45° field of view — 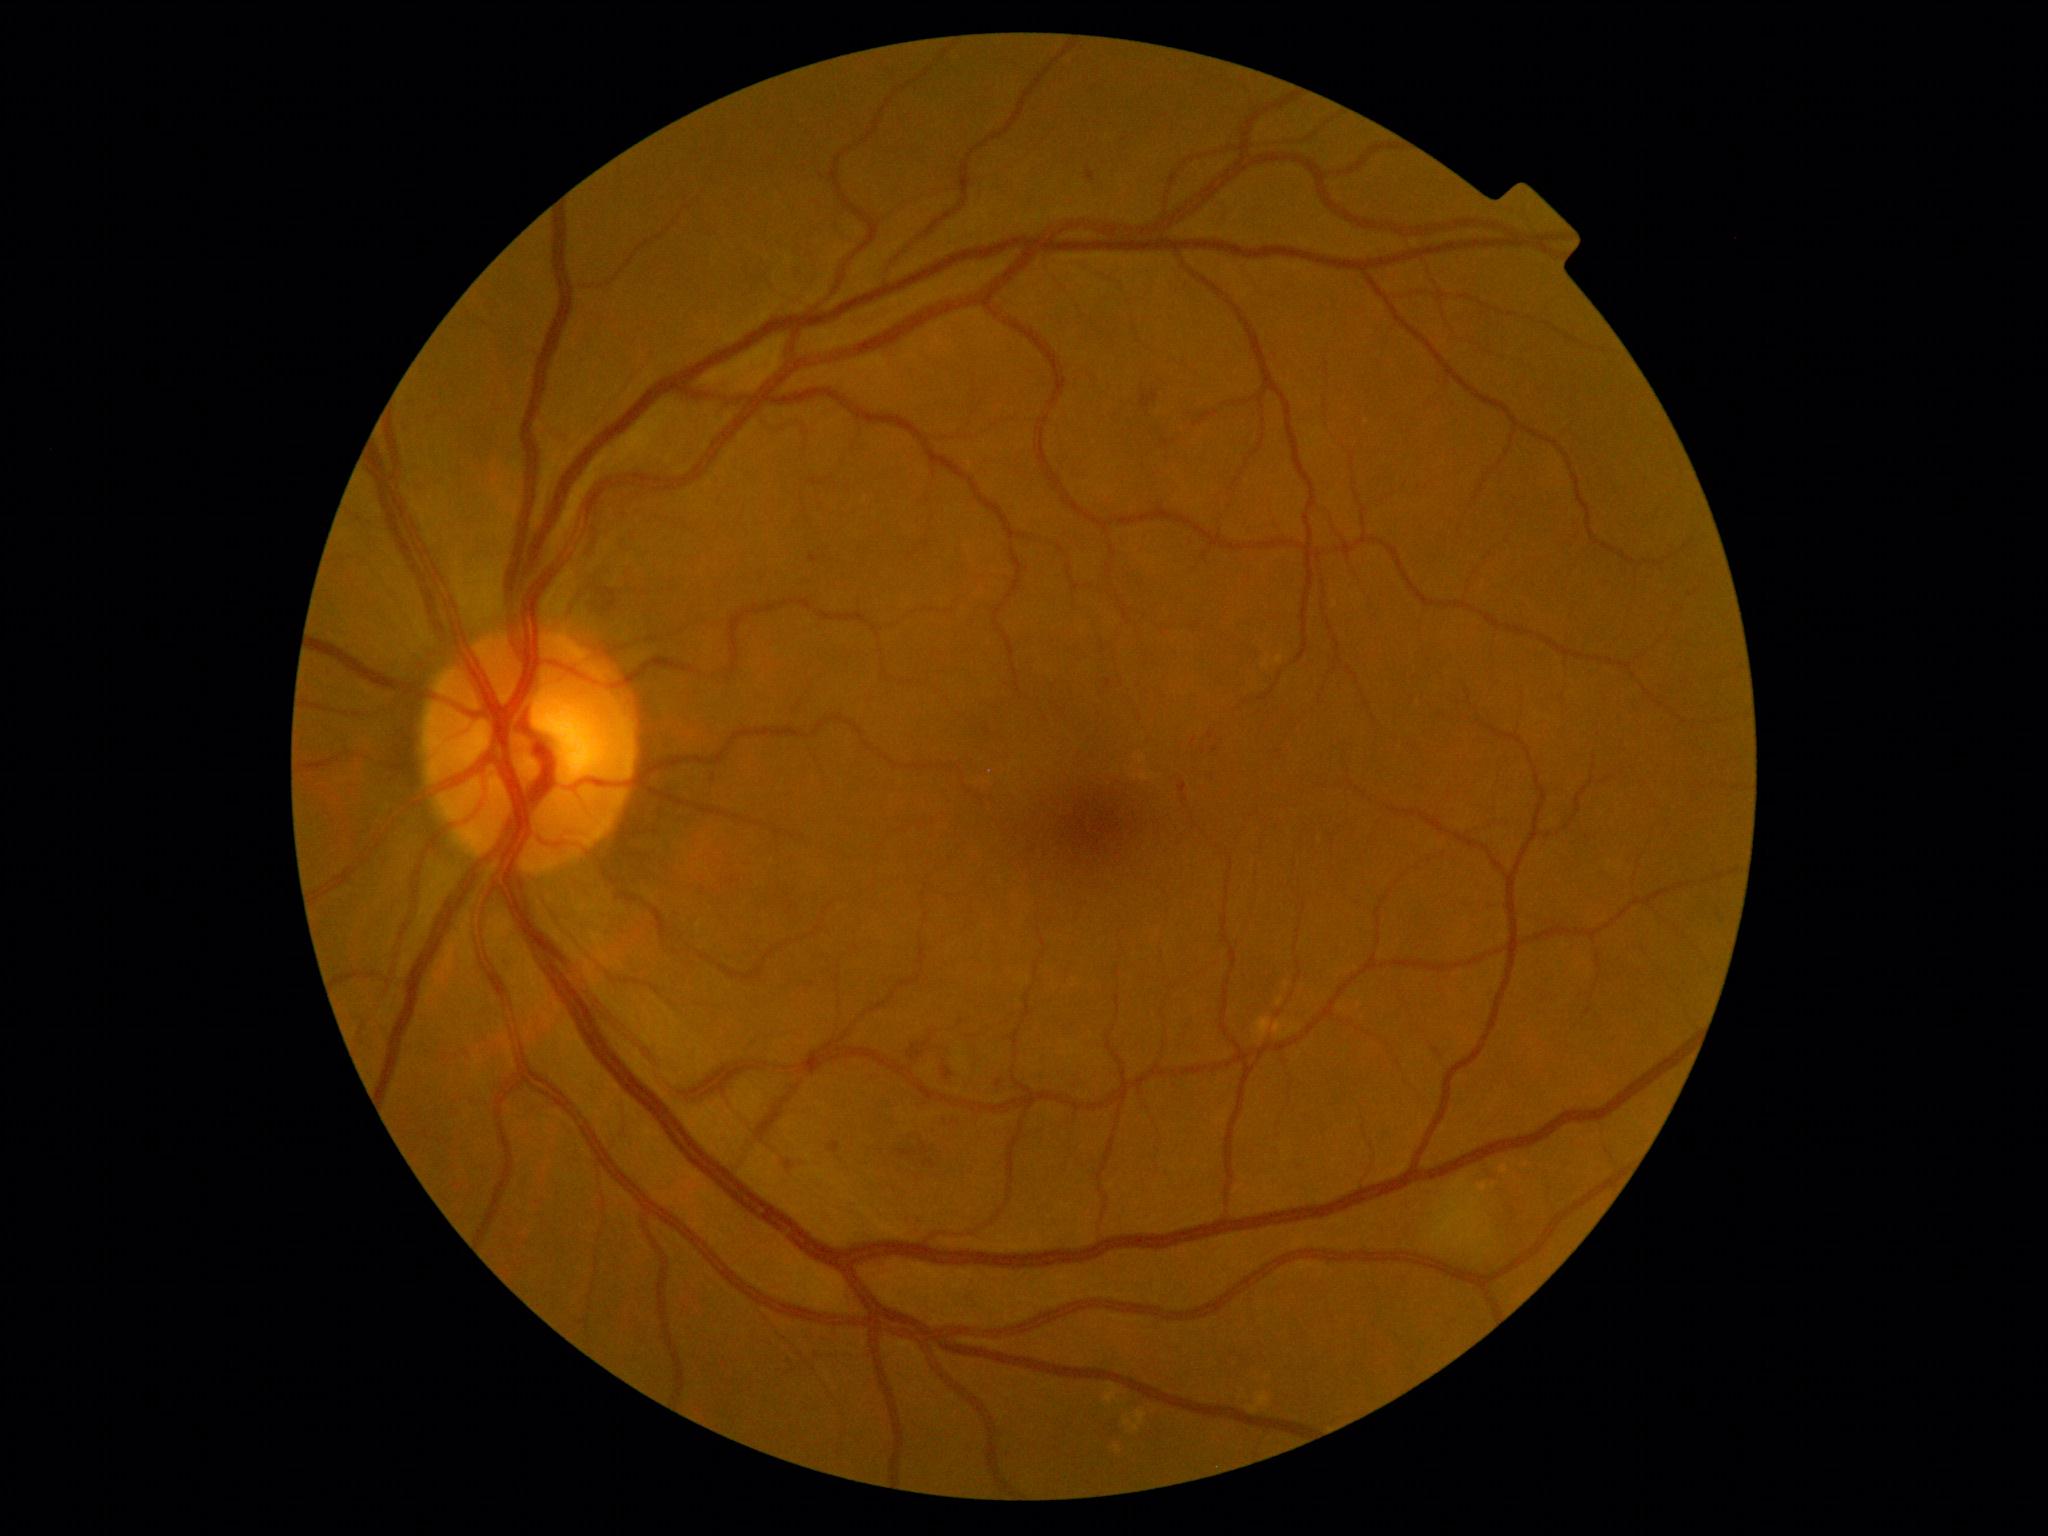 DR grade is 2.